Fundus photo; 1932 by 1910 pixels
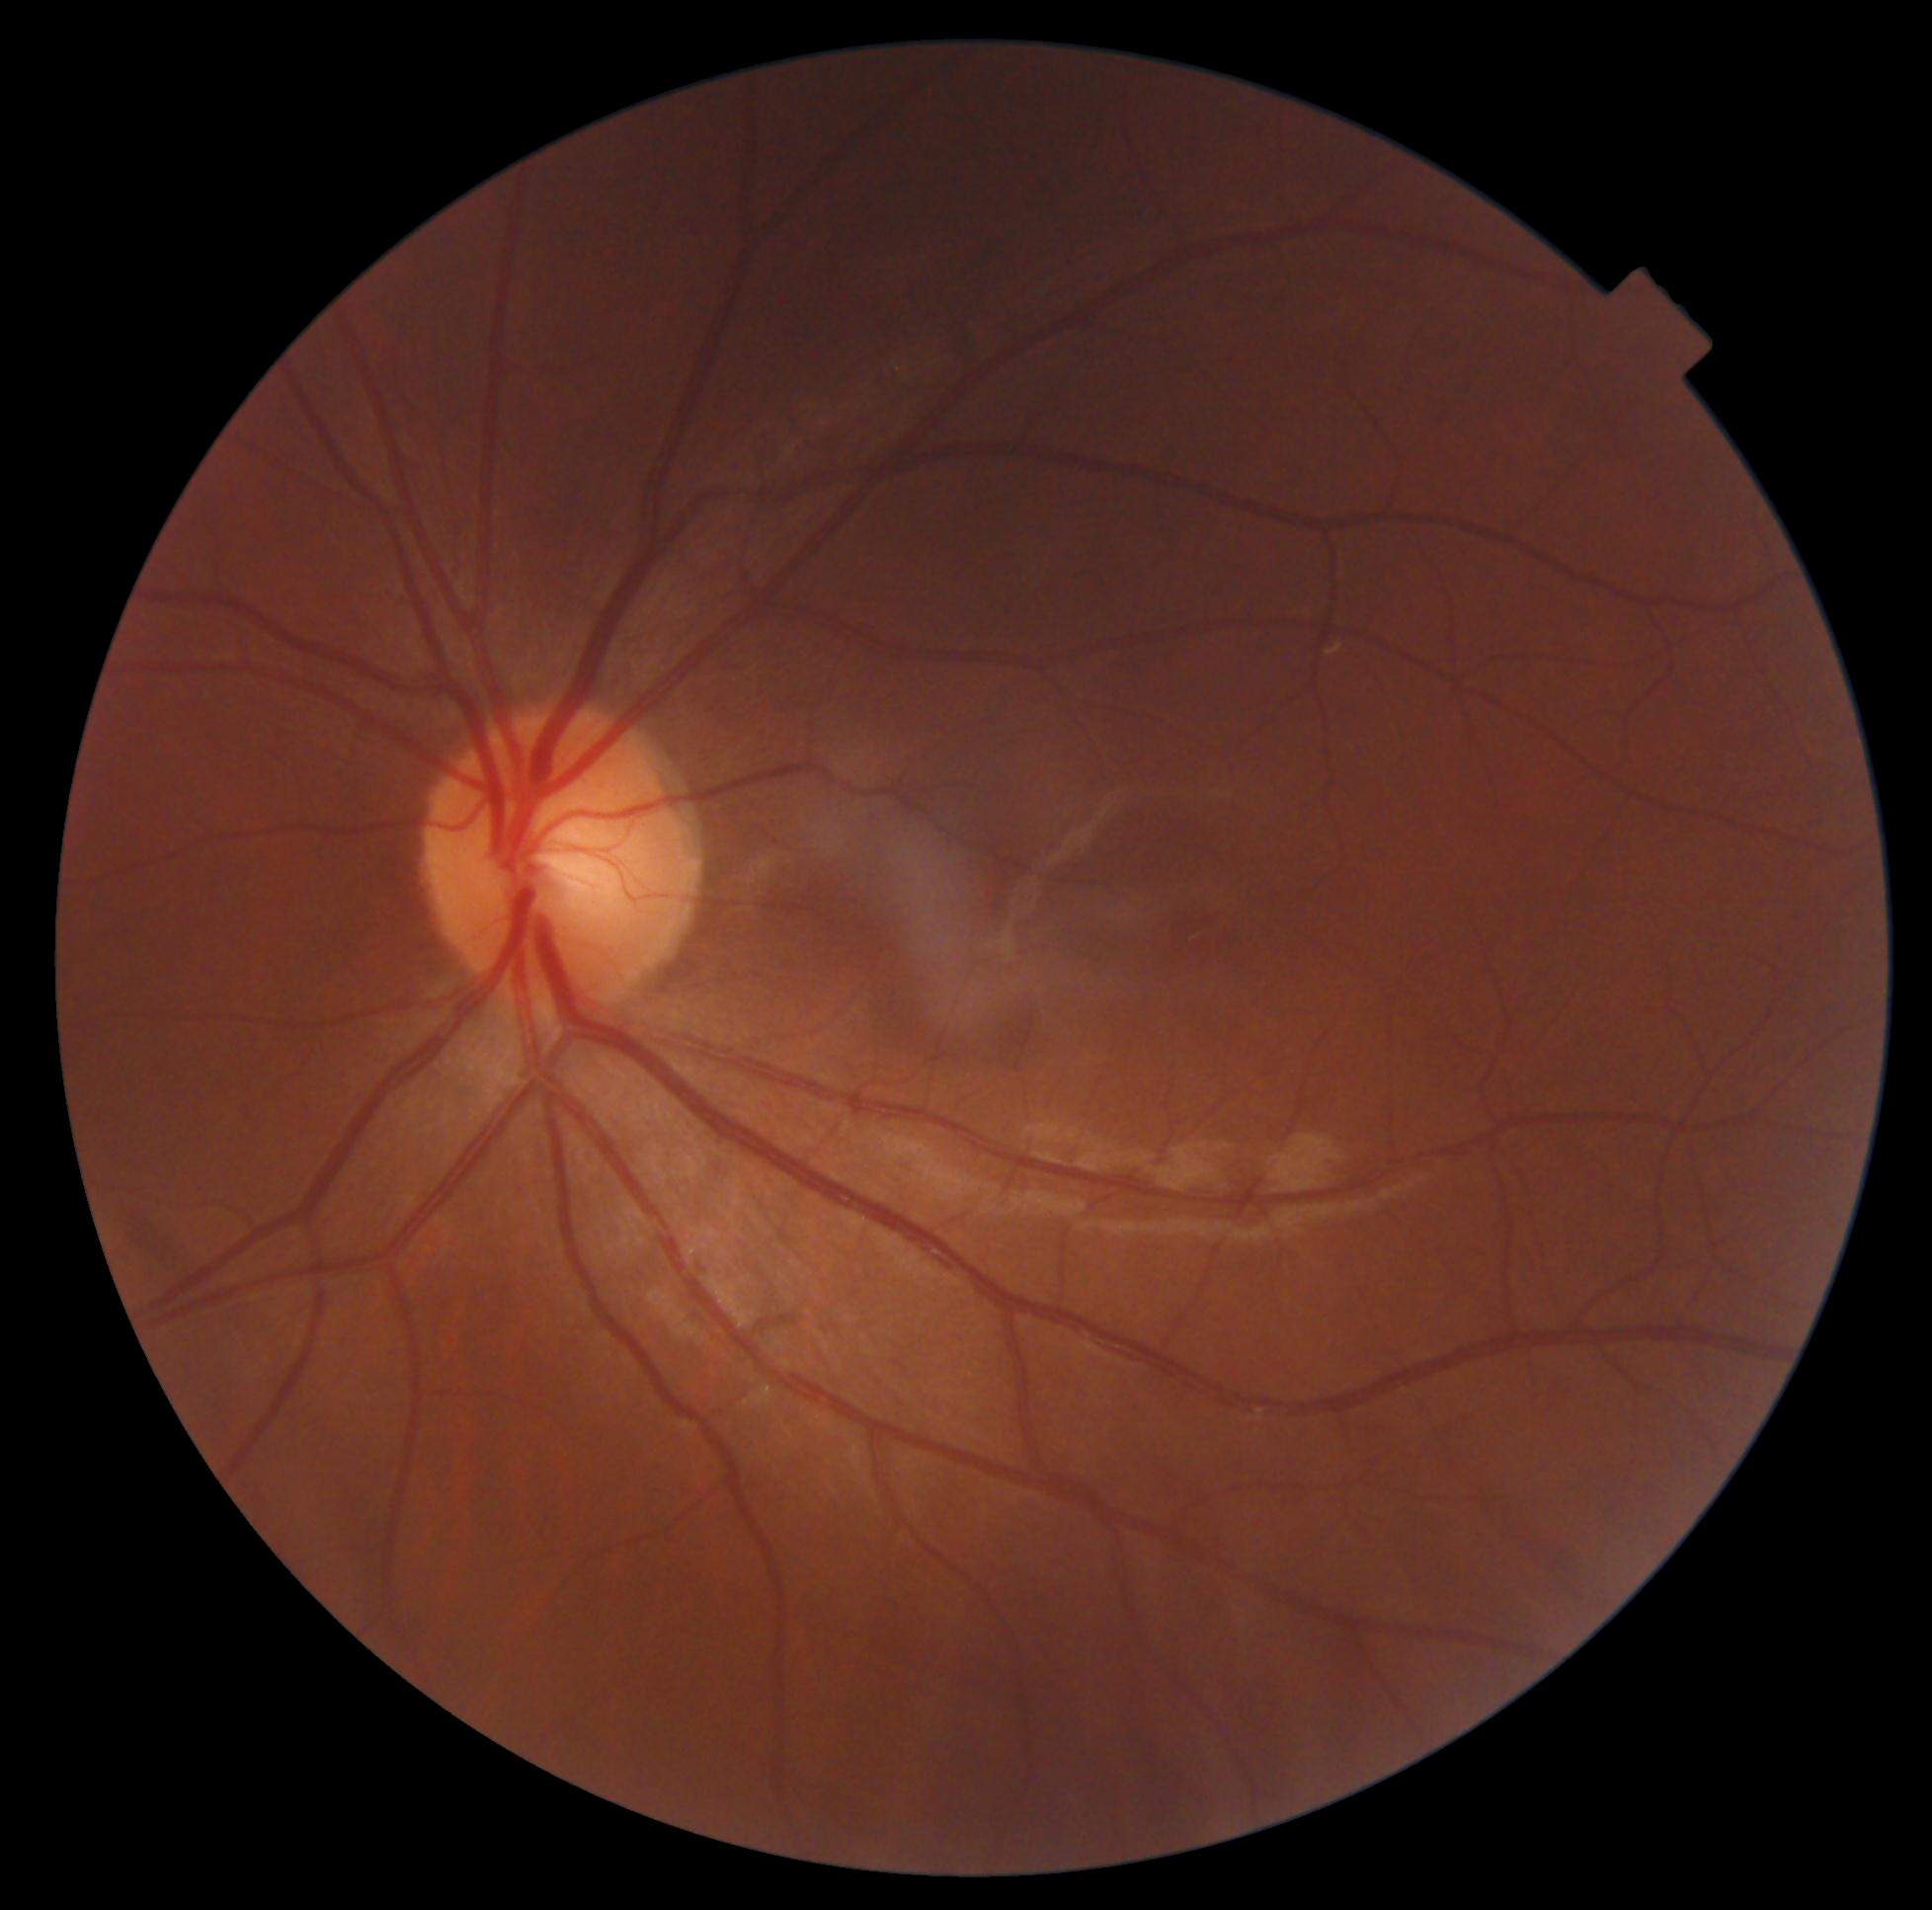

DR stage: no apparent retinopathy (grade 0).